NIDEK AFC-230 fundus camera — 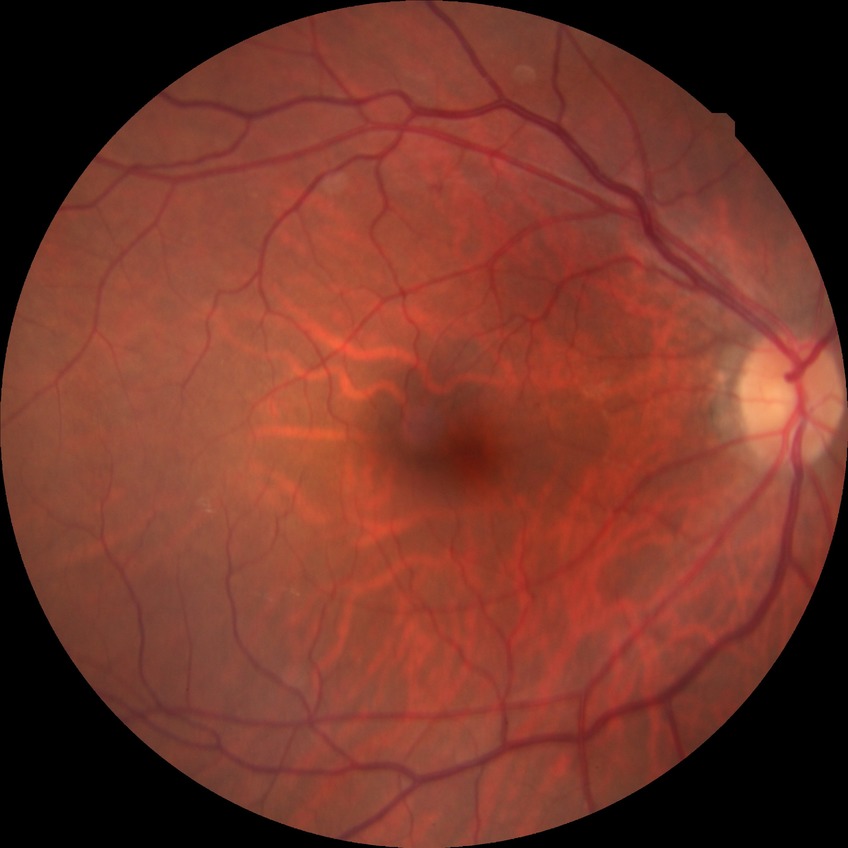
Findings:
* DR impression: no apparent DR
* DR stage: NDR